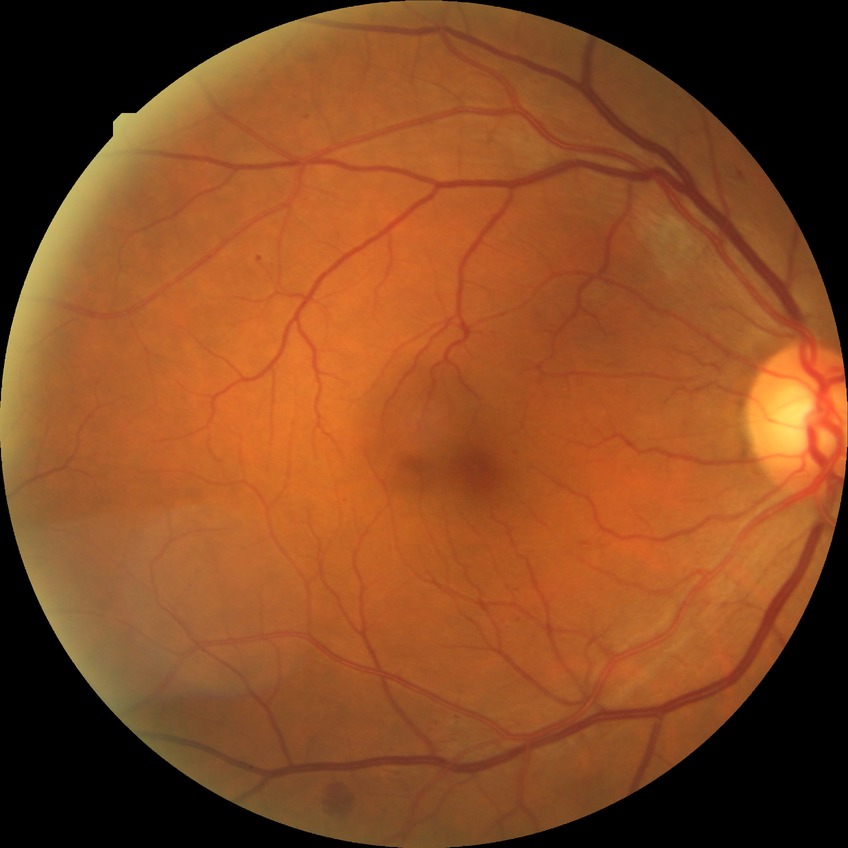
Assessment:
– DR class — non-proliferative diabetic retinopathy
– diabetic retinopathy (DR) — SDR (simple diabetic retinopathy)